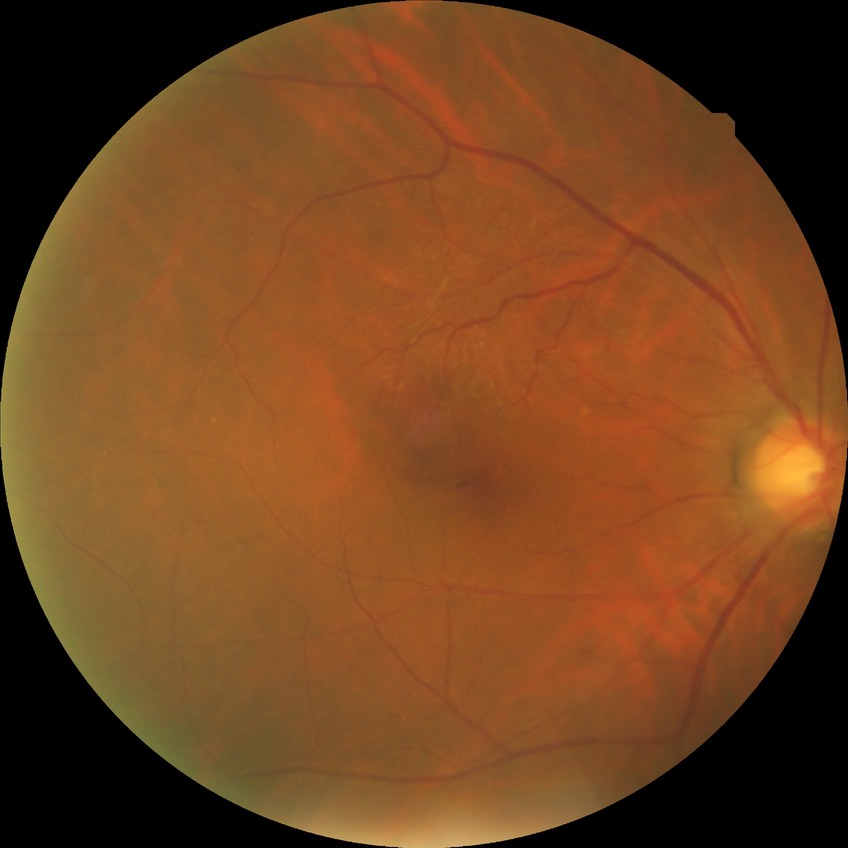
Findings:
• diabetic retinopathy (DR): NDR (no diabetic retinopathy)